Wide-field fundus photograph from neonatal ROP screening; 640x480px — 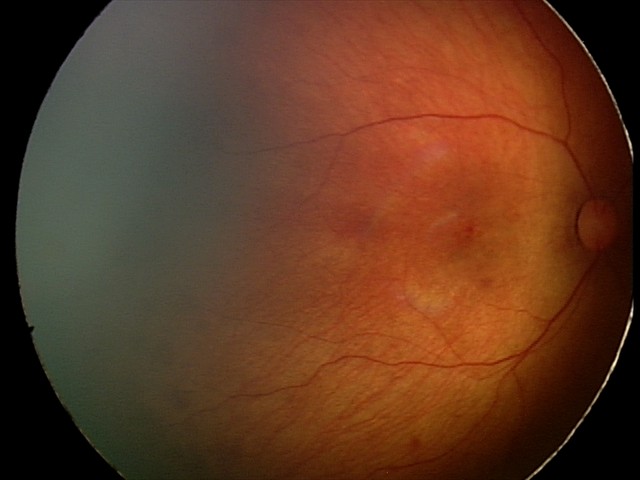 Examination diagnosed as retinal hemorrhages.